RetCam wide-field infant fundus image; acquired on the Clarity RetCam 3:
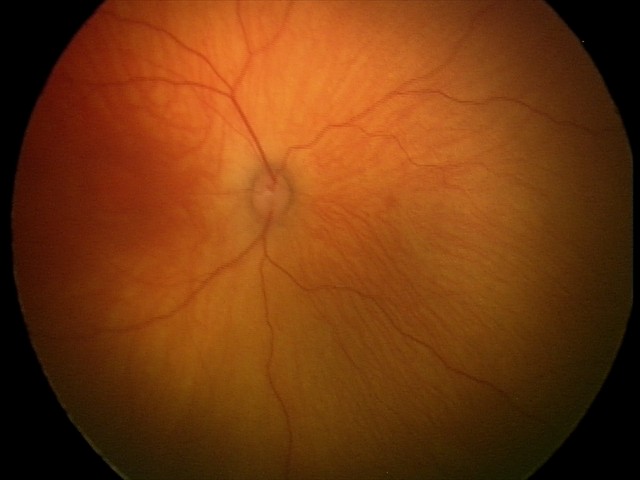
Physiological retinal appearance for postconceptual age.